NIDEK AFC-230: 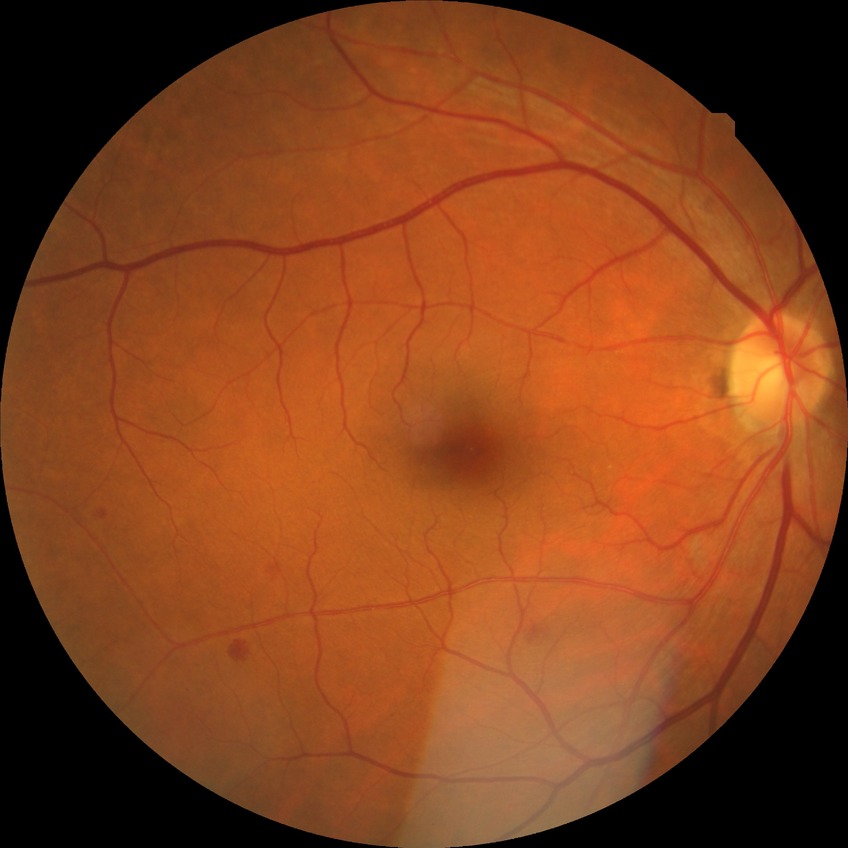 diabetic retinopathy (DR)=SDR (simple diabetic retinopathy).